NIDEK AFC-230 · posterior pole color fundus photograph · 45 degree fundus photograph — 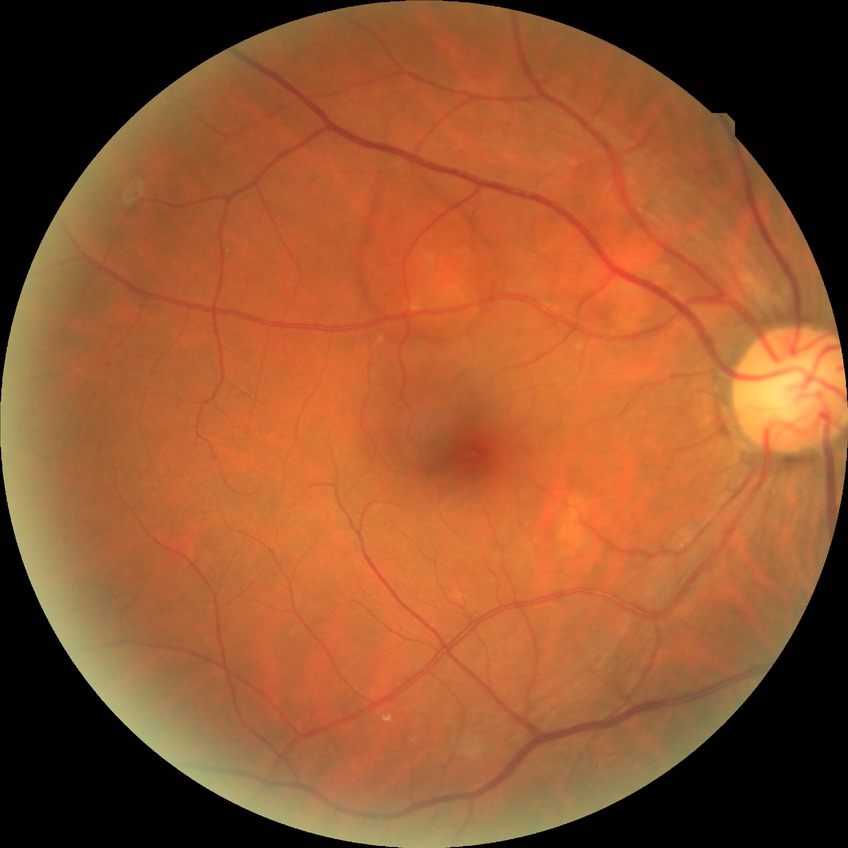
Diabetic retinopathy grade is no diabetic retinopathy.